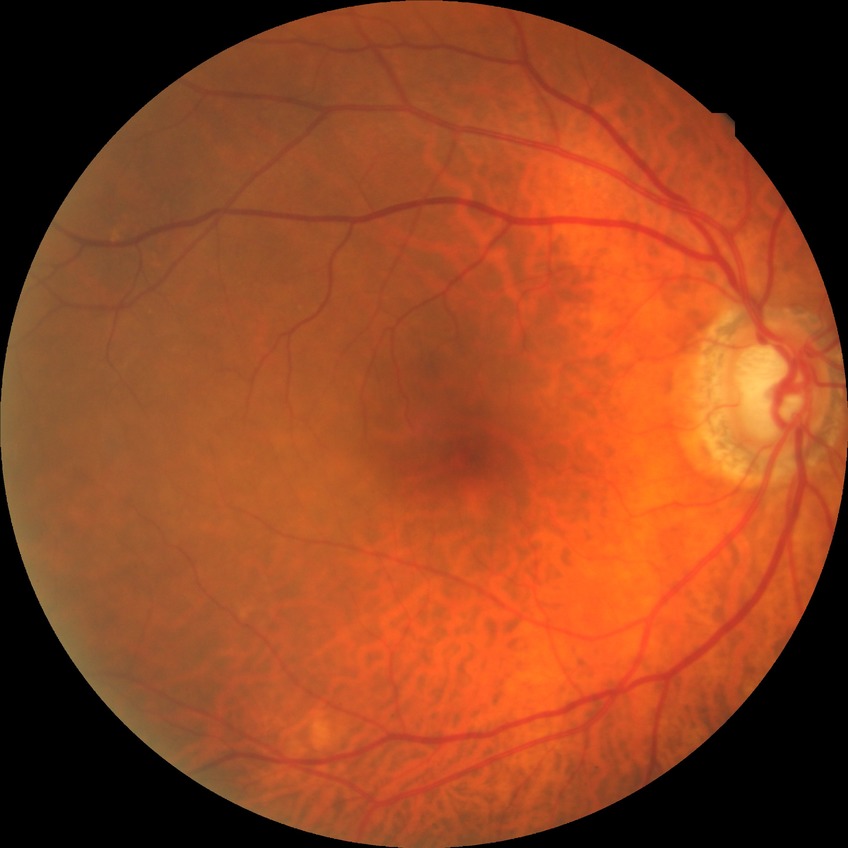

No DR findings. DR stage: NDR.